FOV: 45 degrees, NIDEK AFC-230 fundus camera:
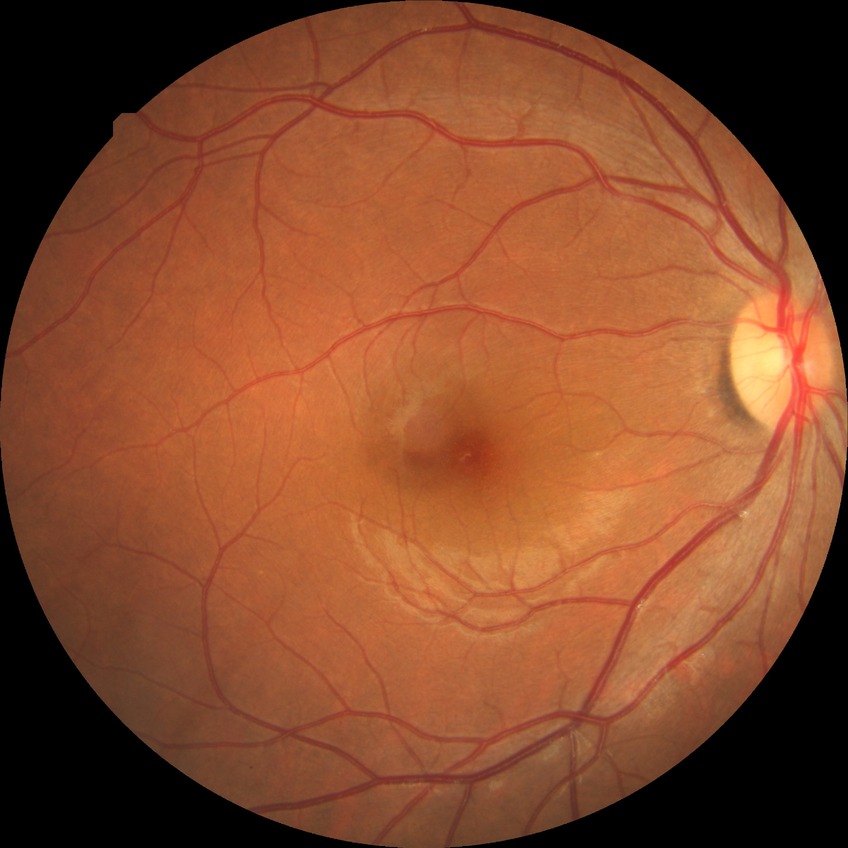

DR severity: NDR. No apparent diabetic retinopathy.